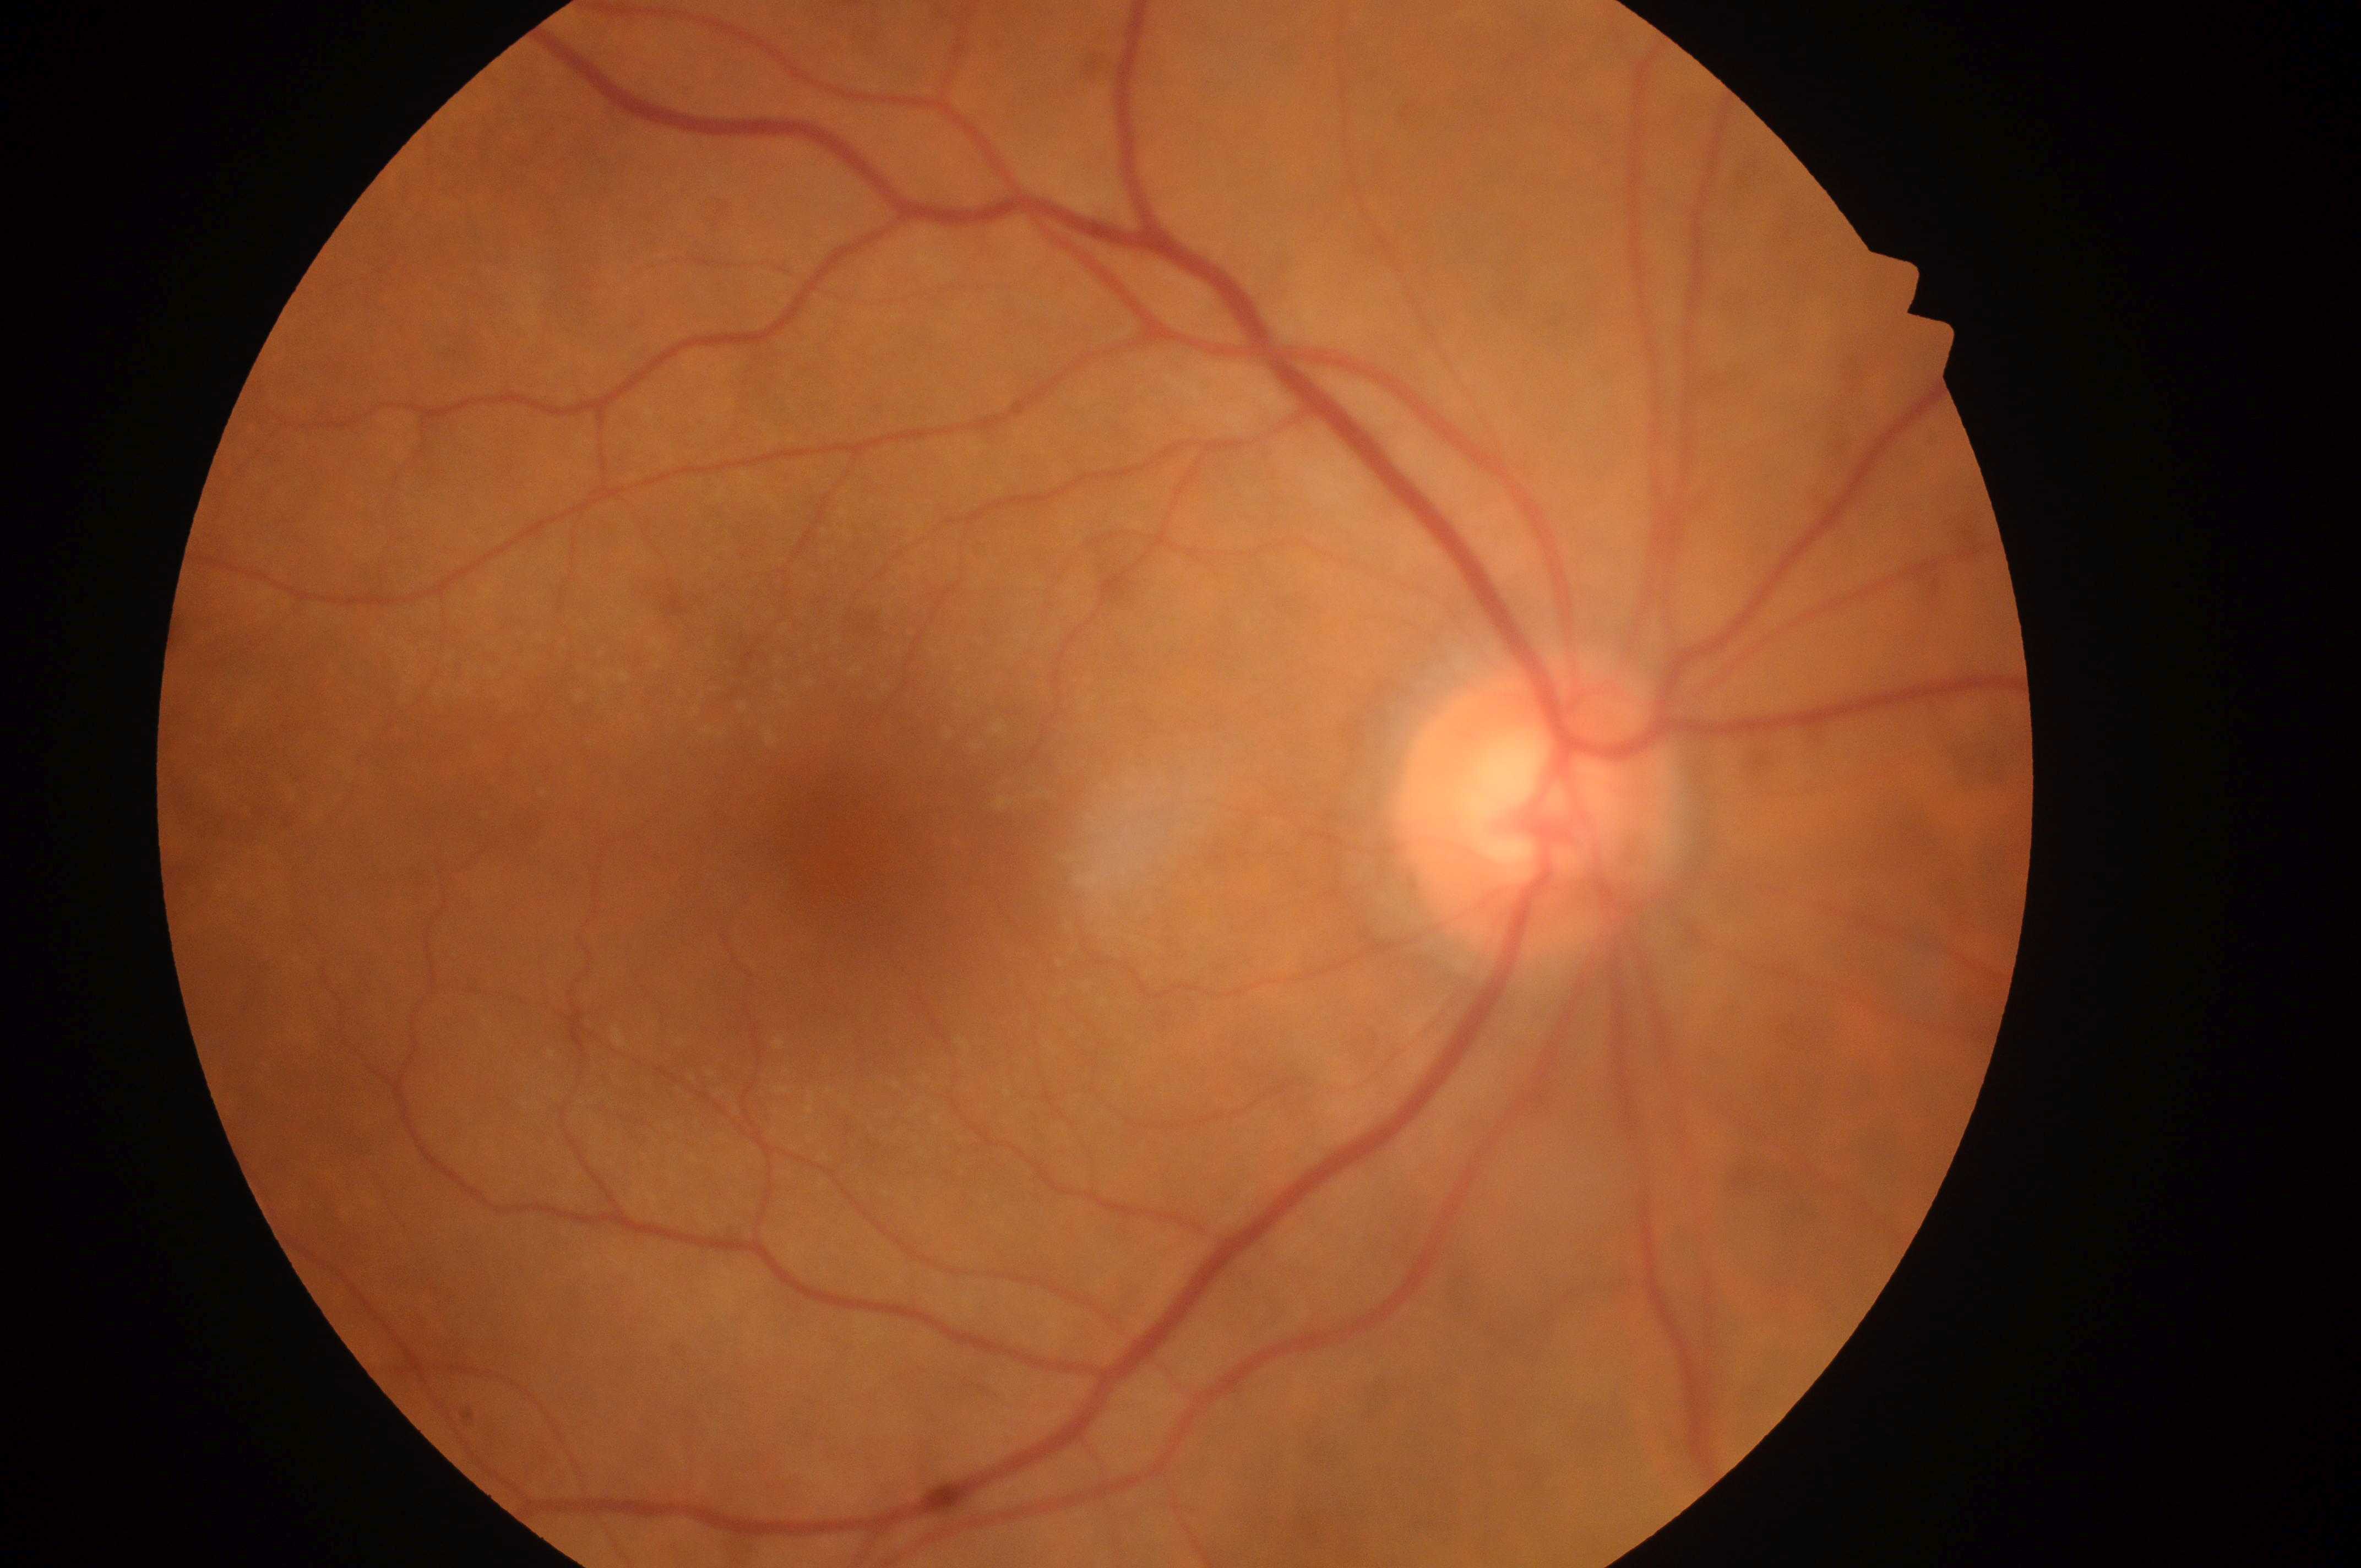
Findings:
– foveal center — (x: 852, y: 858)
– optic disc center — (x: 1531, y: 812)
– diabetic retinopathy (DR) — grade 0
– diabetic macular edema (DME) — 0
– DR impression — No DR or DME findings
– laterality — right eye